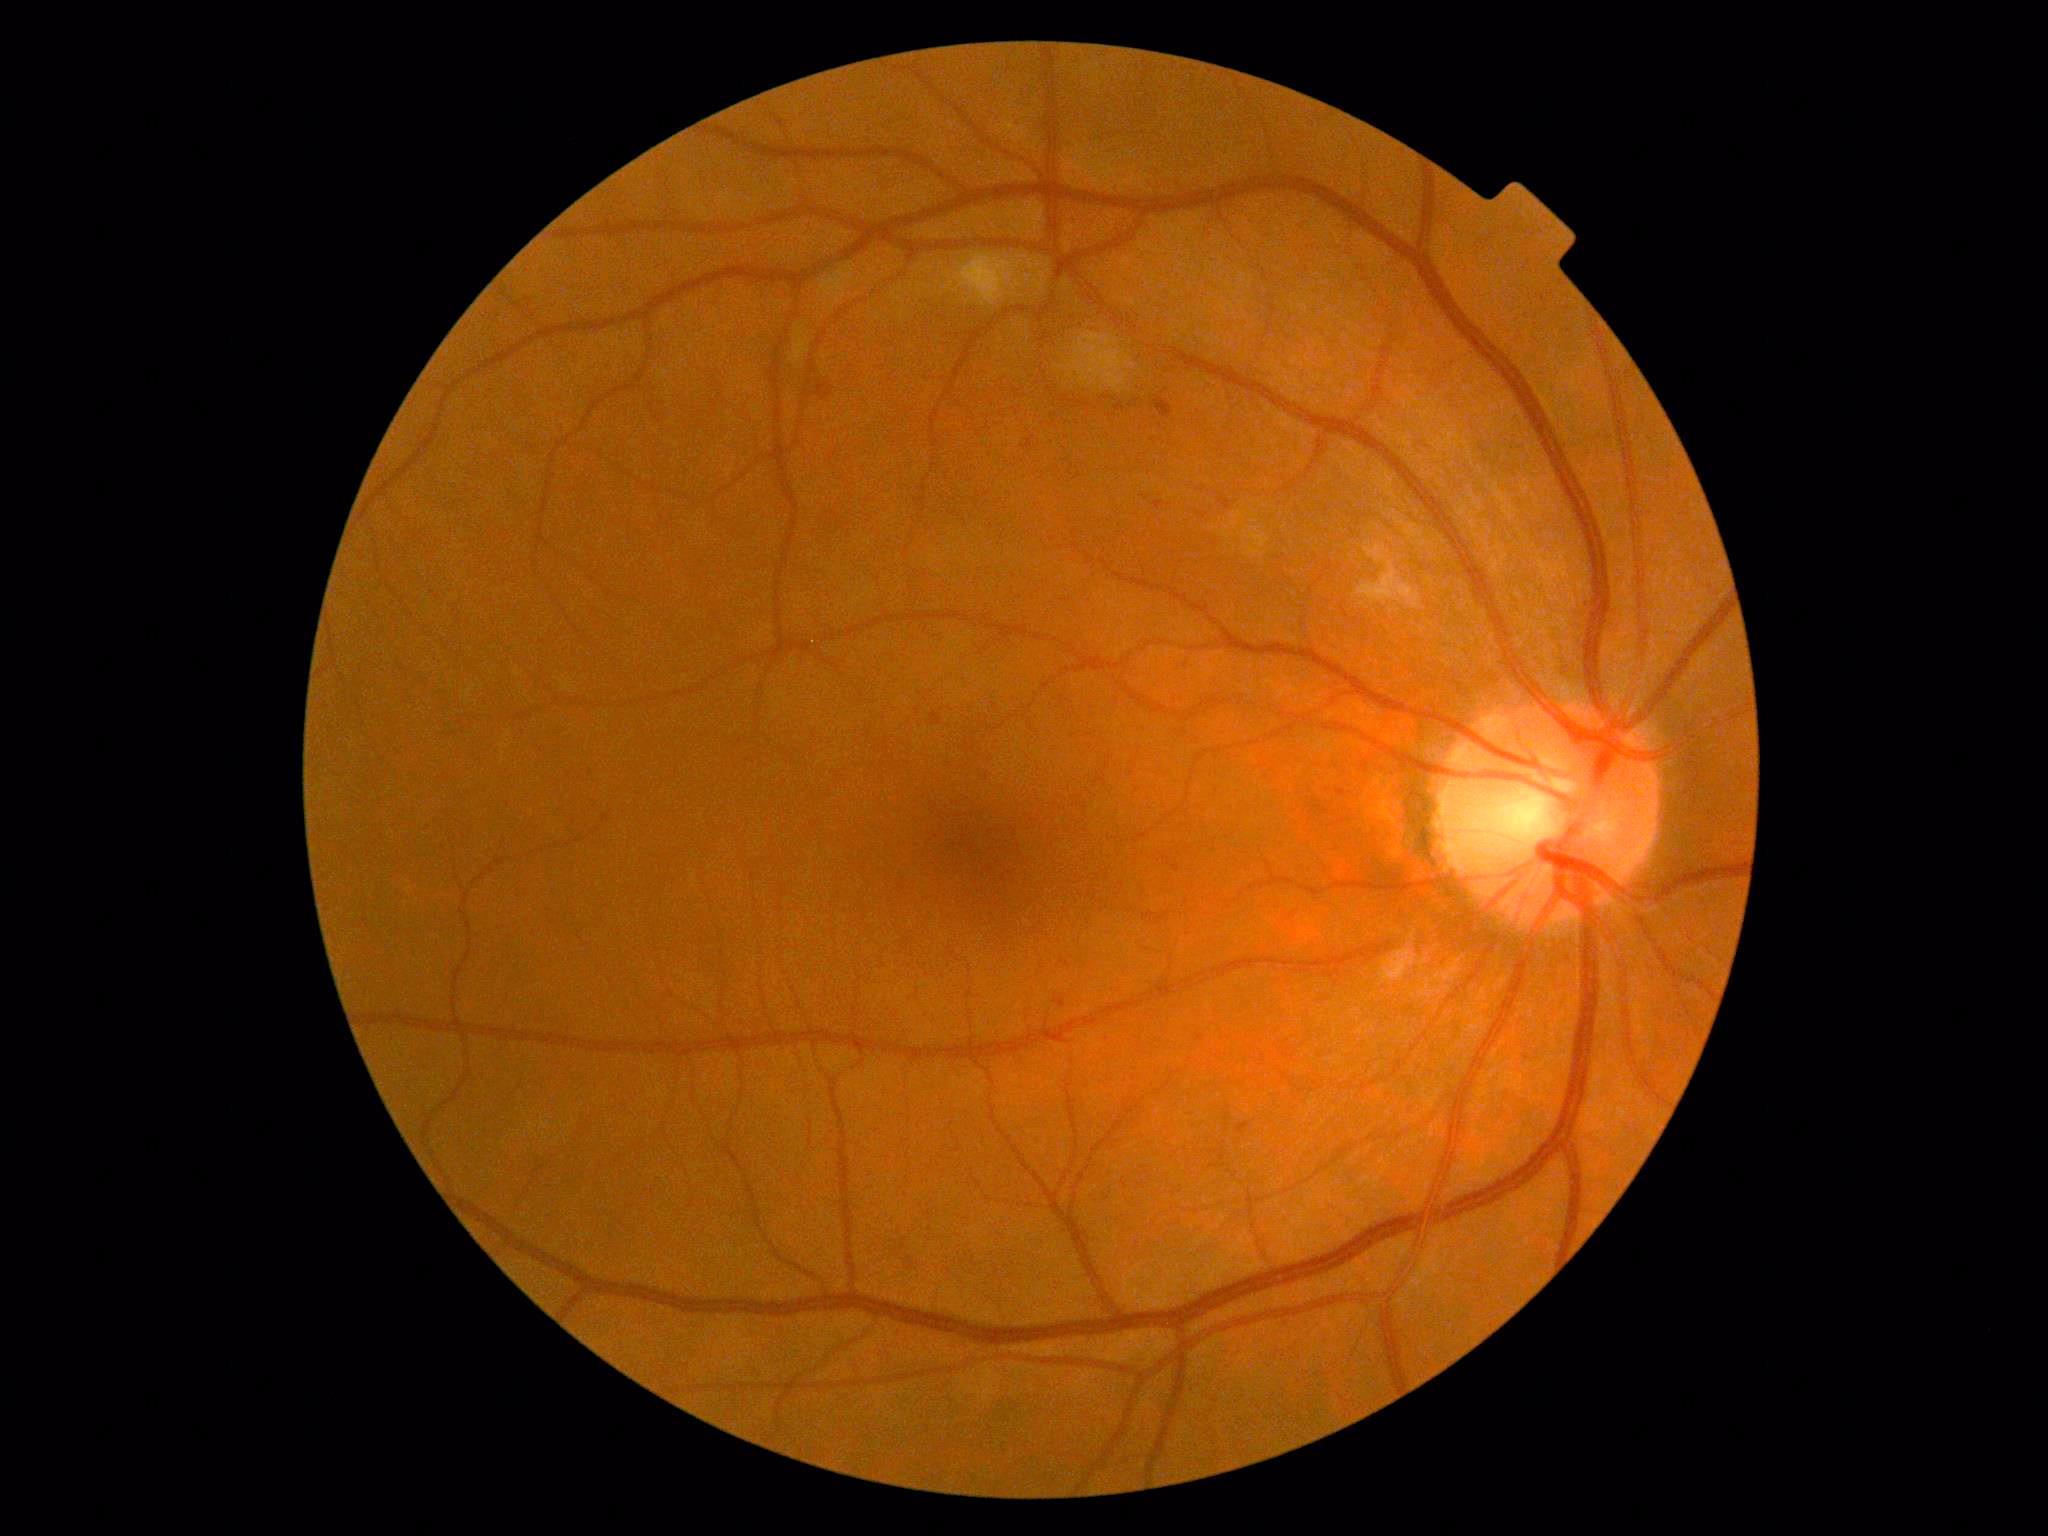
DR is 2 — more than just microaneurysms but less than severe NPDR.